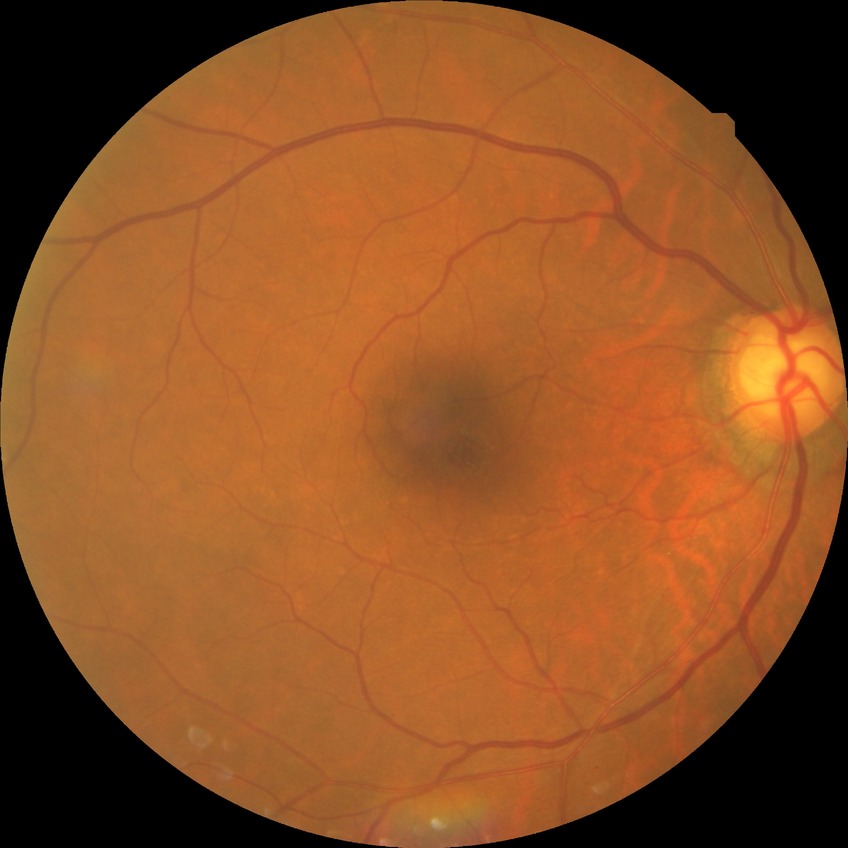 Diabetic retinopathy stage is no diabetic retinopathy.